Centered on the macula, 1932x1932px.
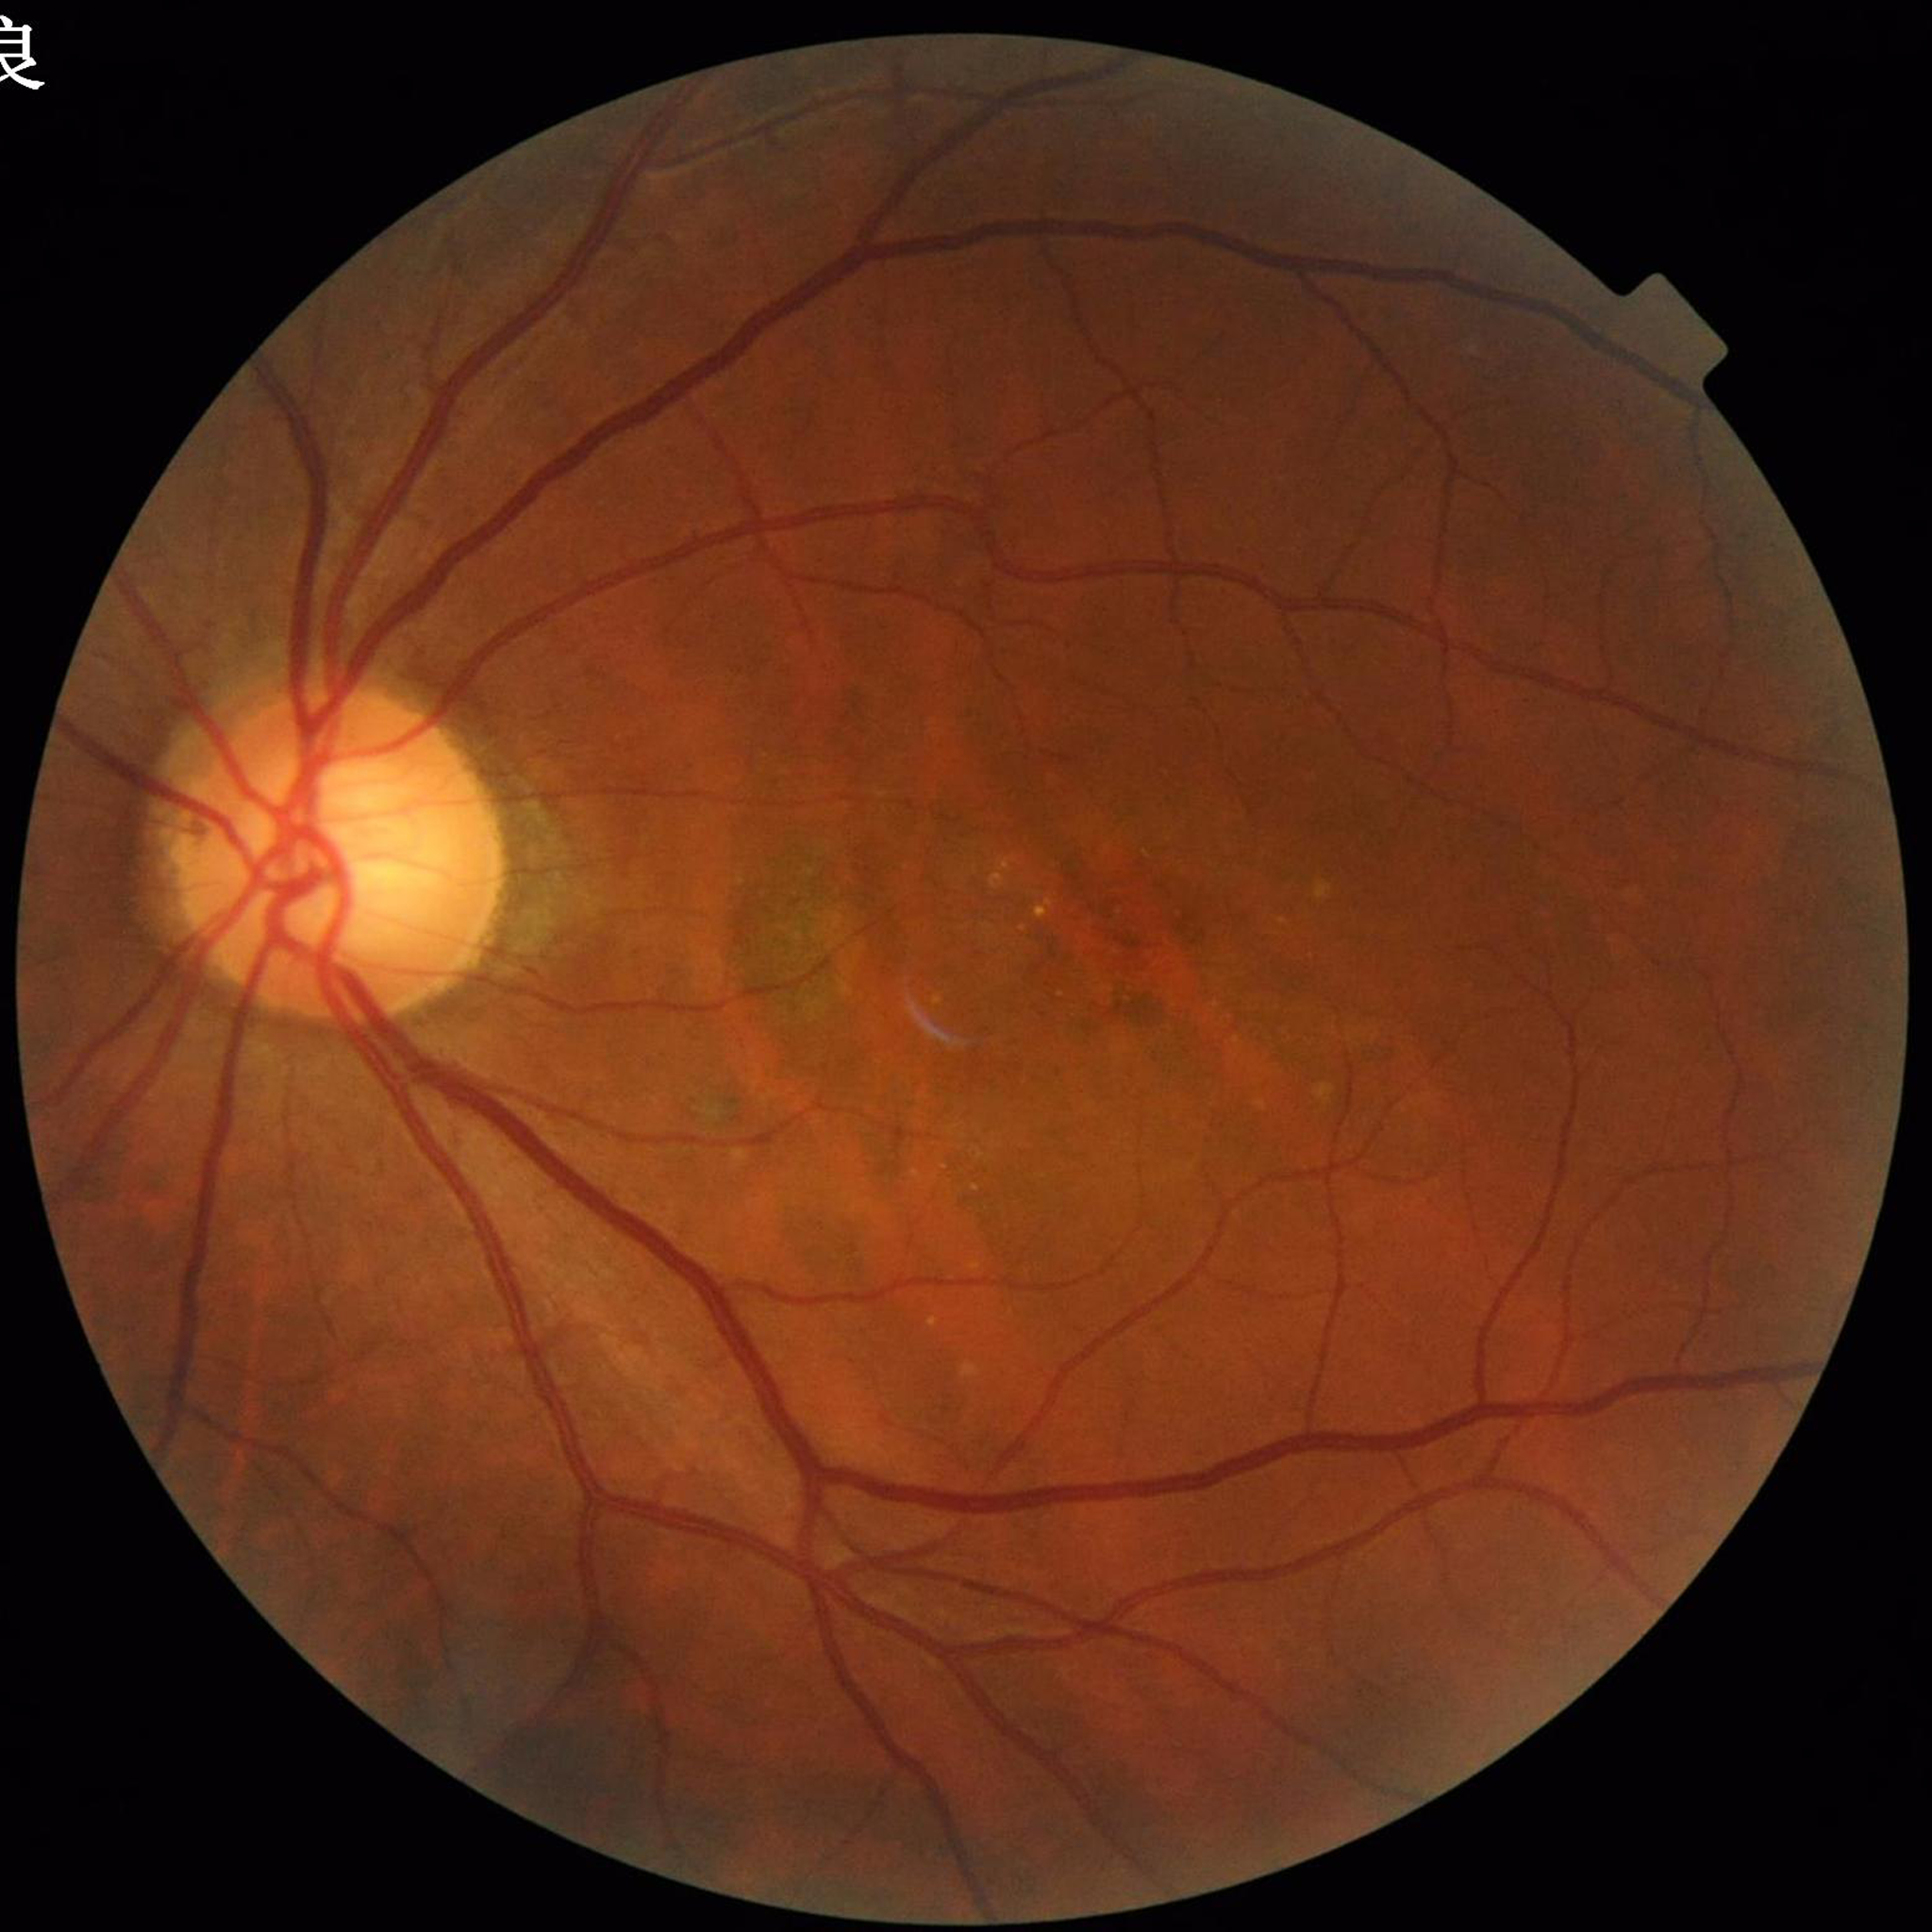 Disease = age-related macular degeneration; Automated quality assessment = illumination and color satisfactory, contrast adequate, no blur.